Image size 2102x1736: 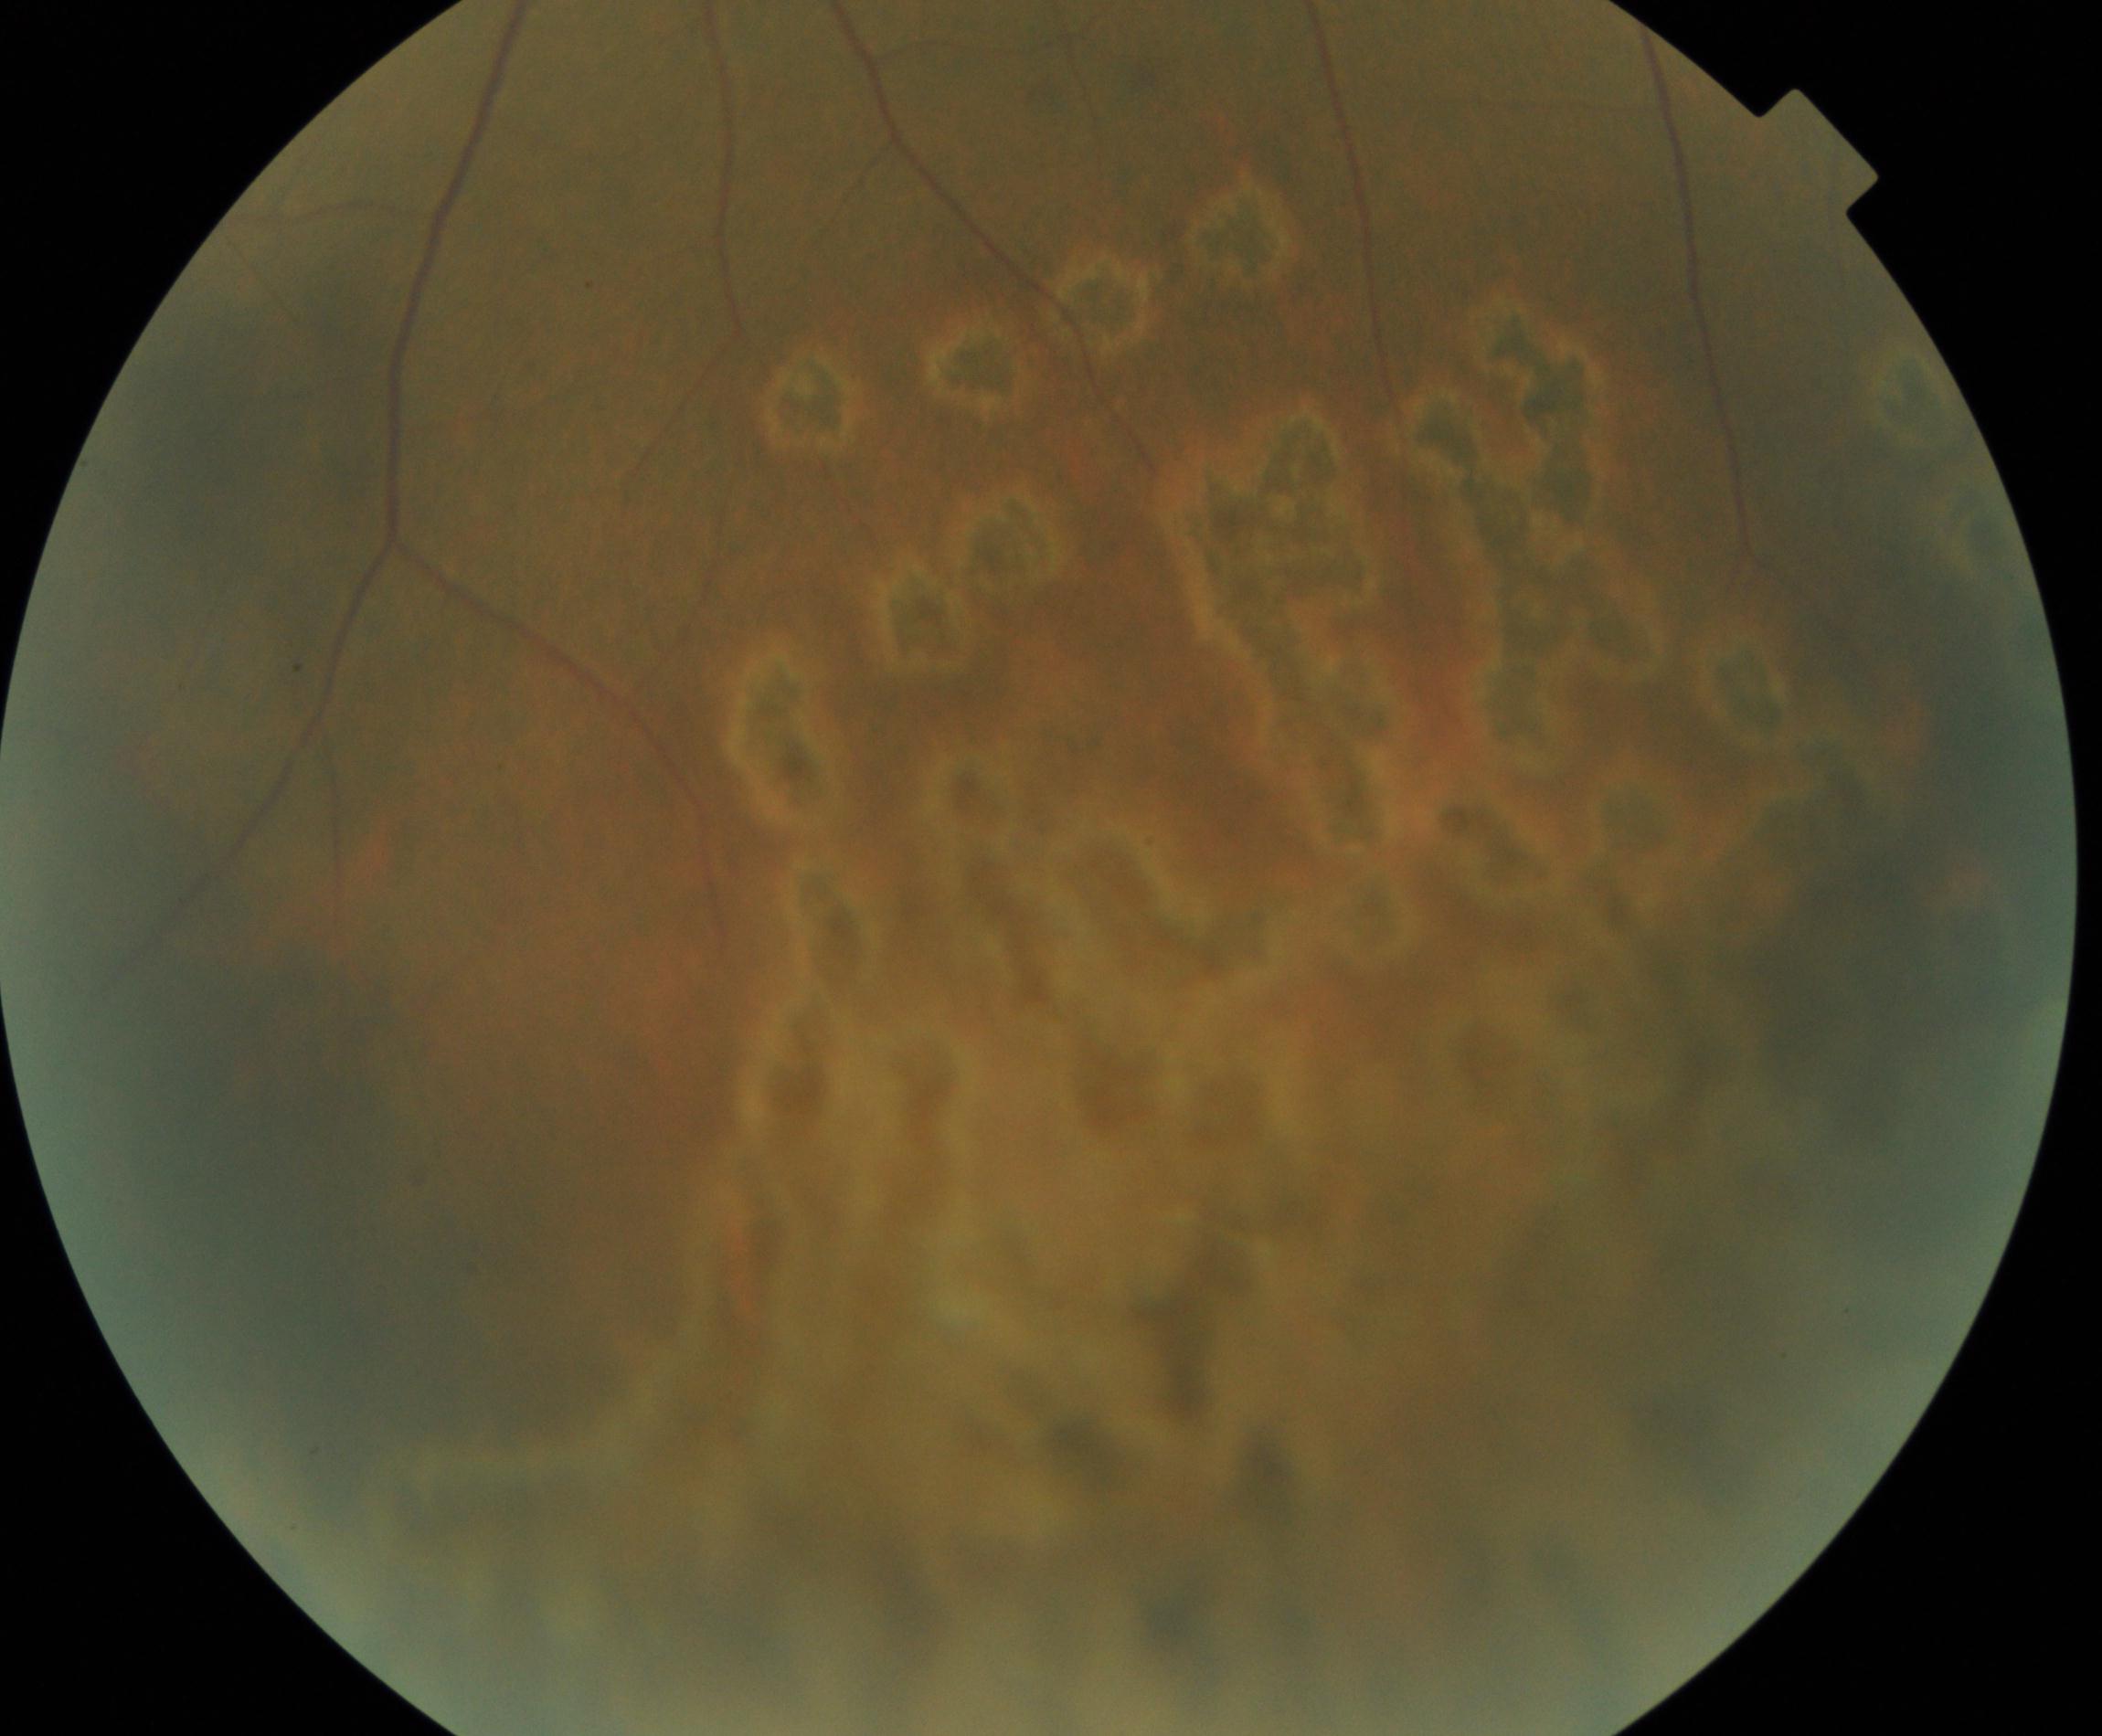
Notable finding: laser spots.